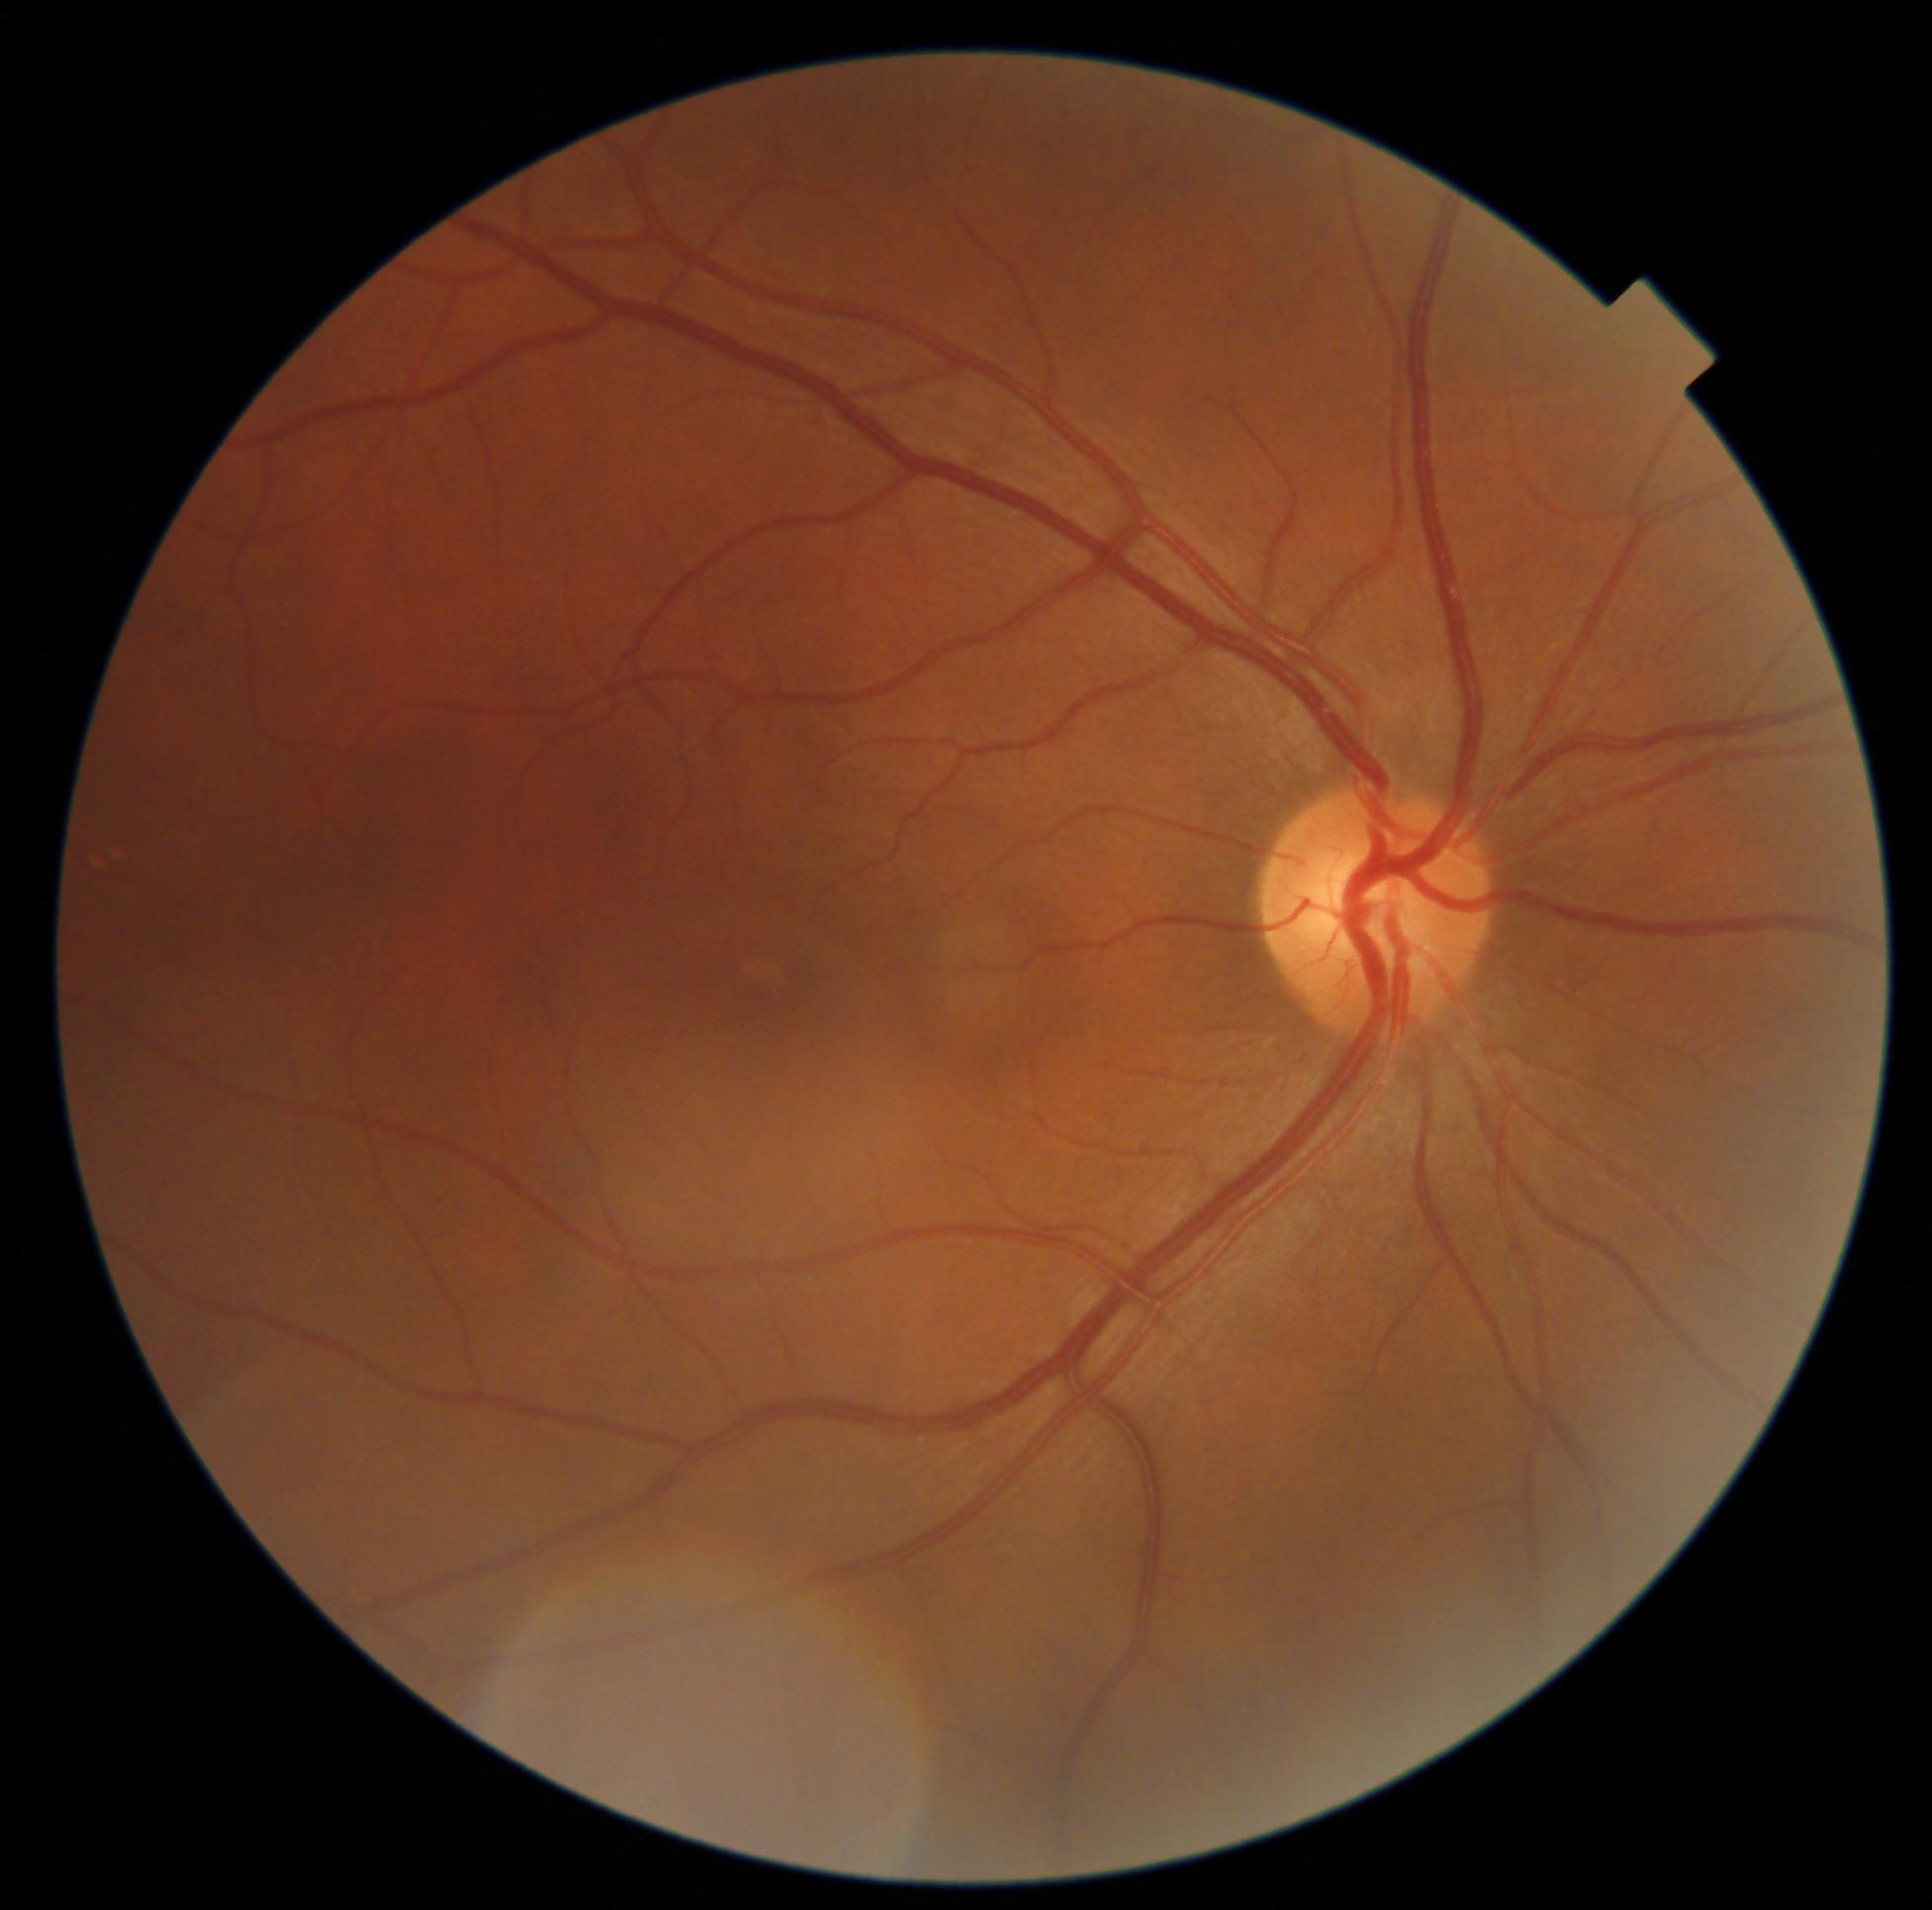 No DR findings. DR grade: 0/4.